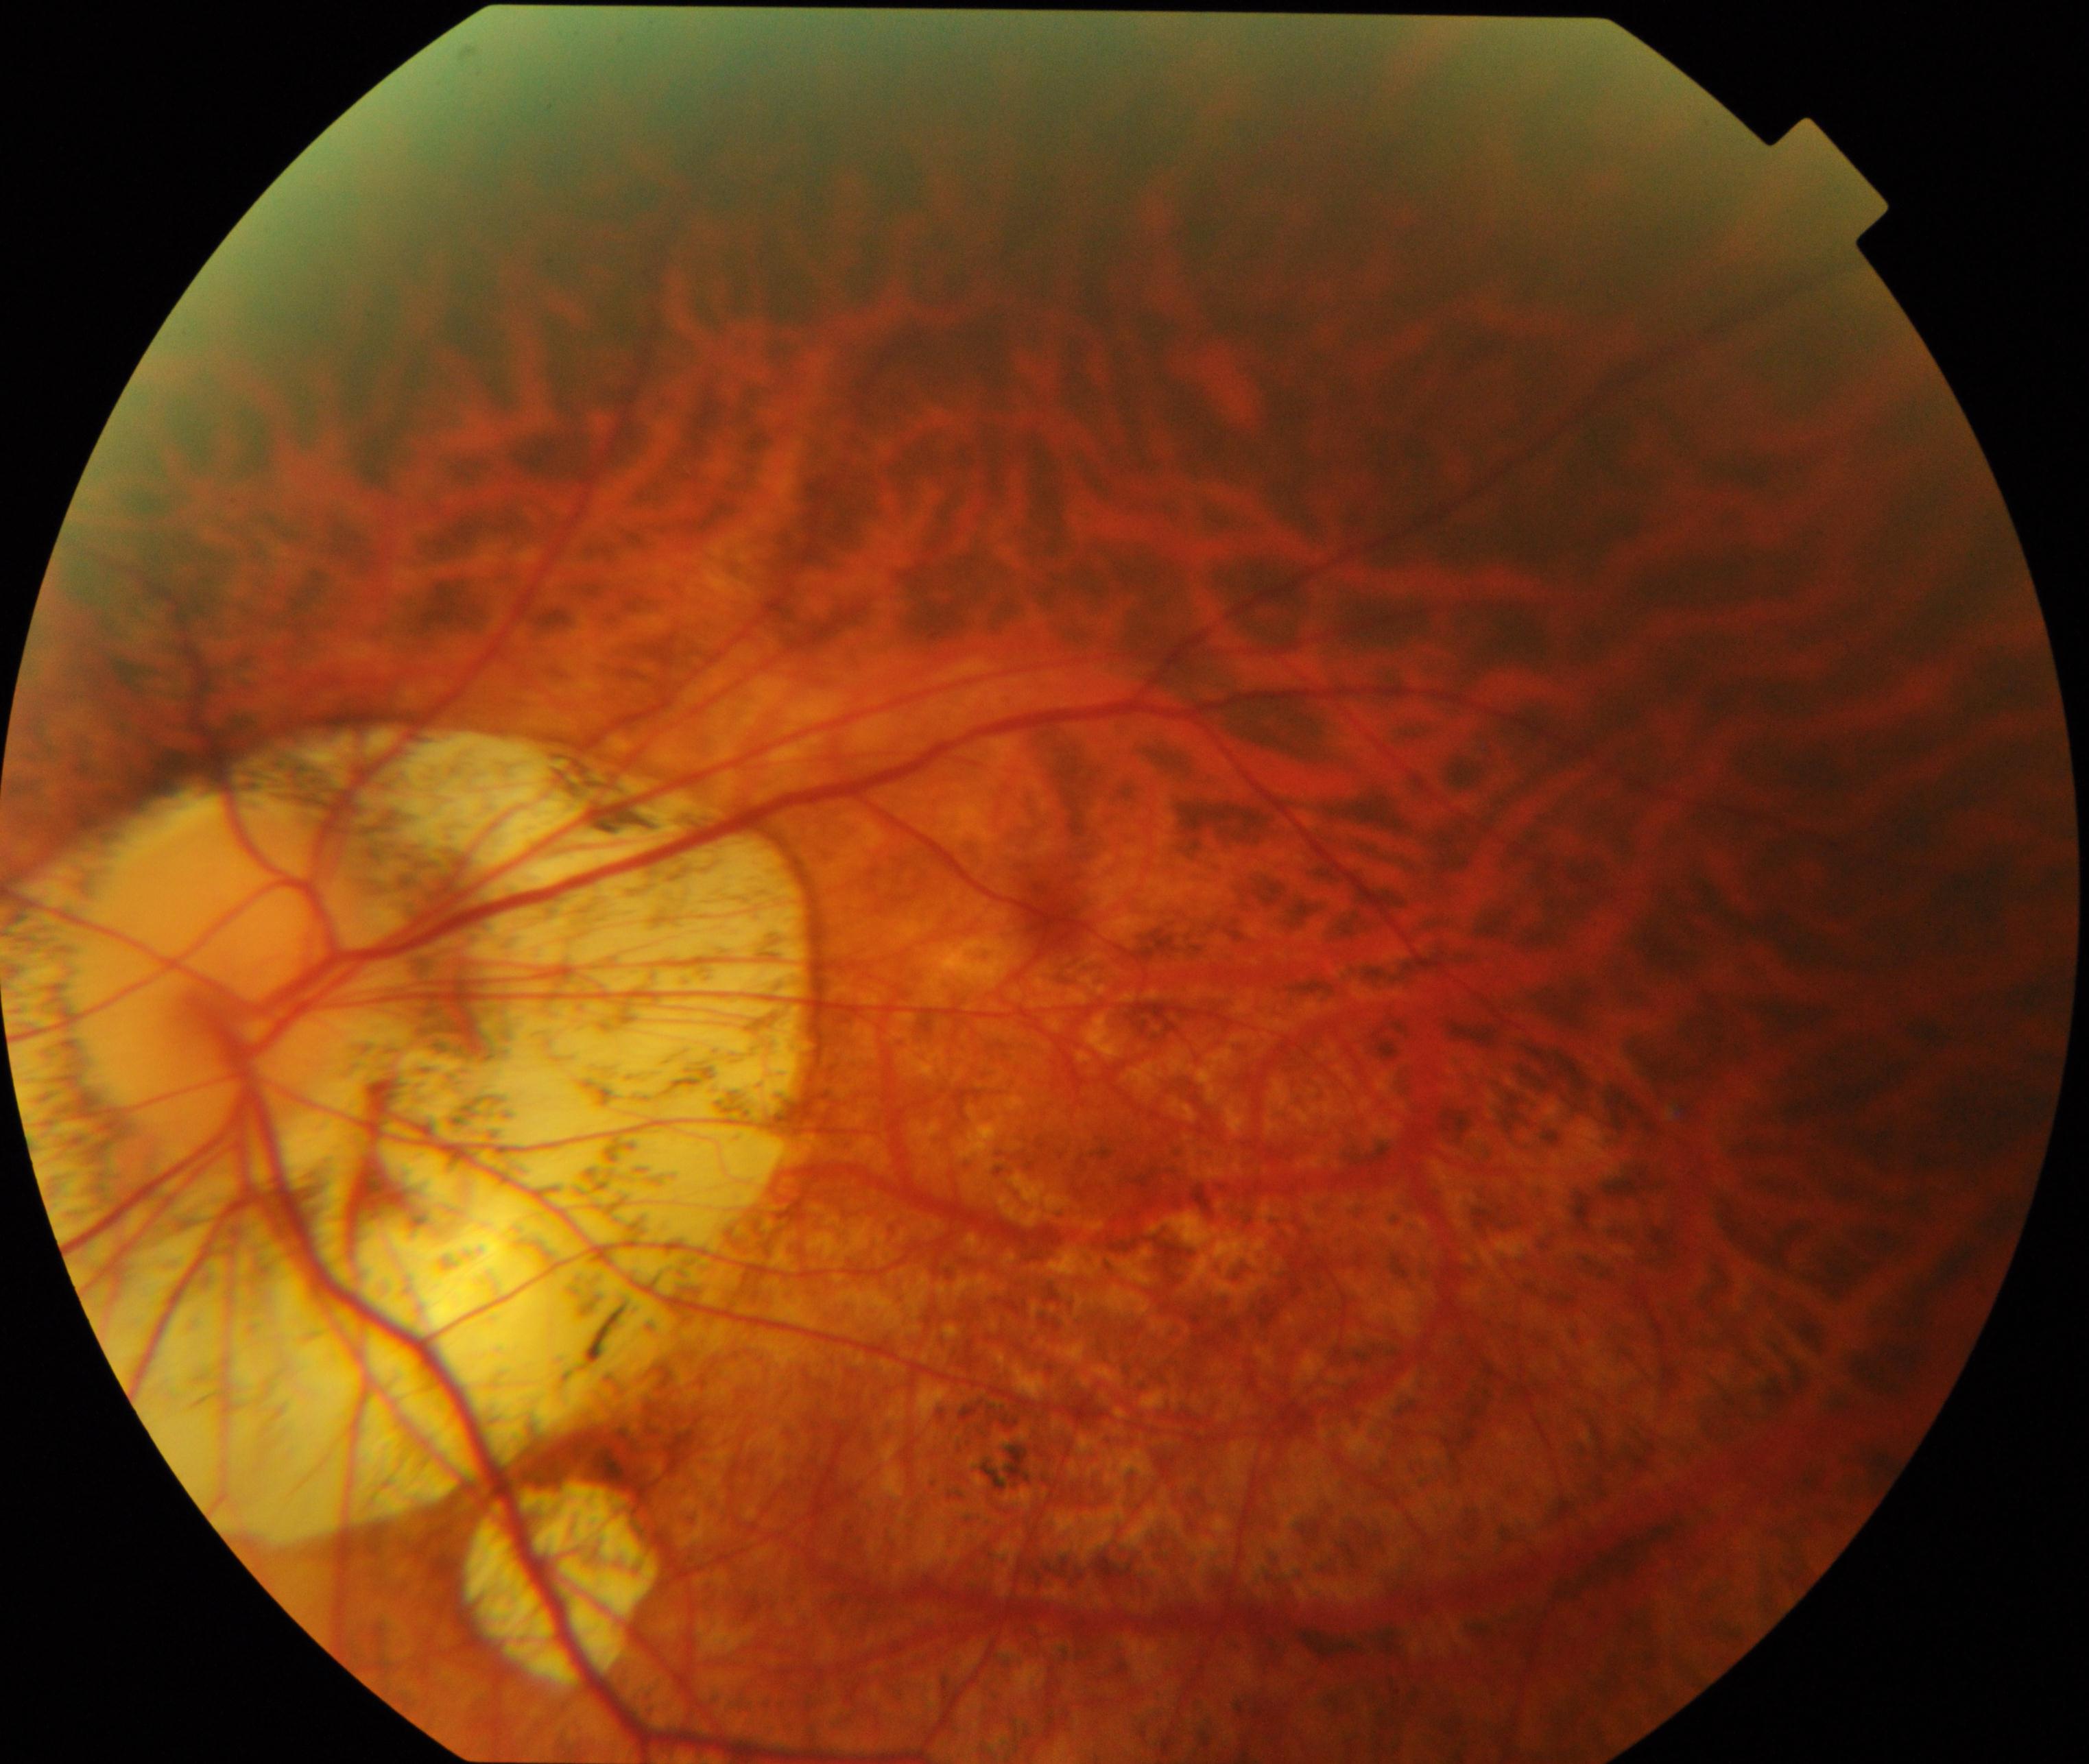

This fundus photograph shows pathological myopia.